Natus RetCam Envision, 130° FOV; infant wide-field retinal image
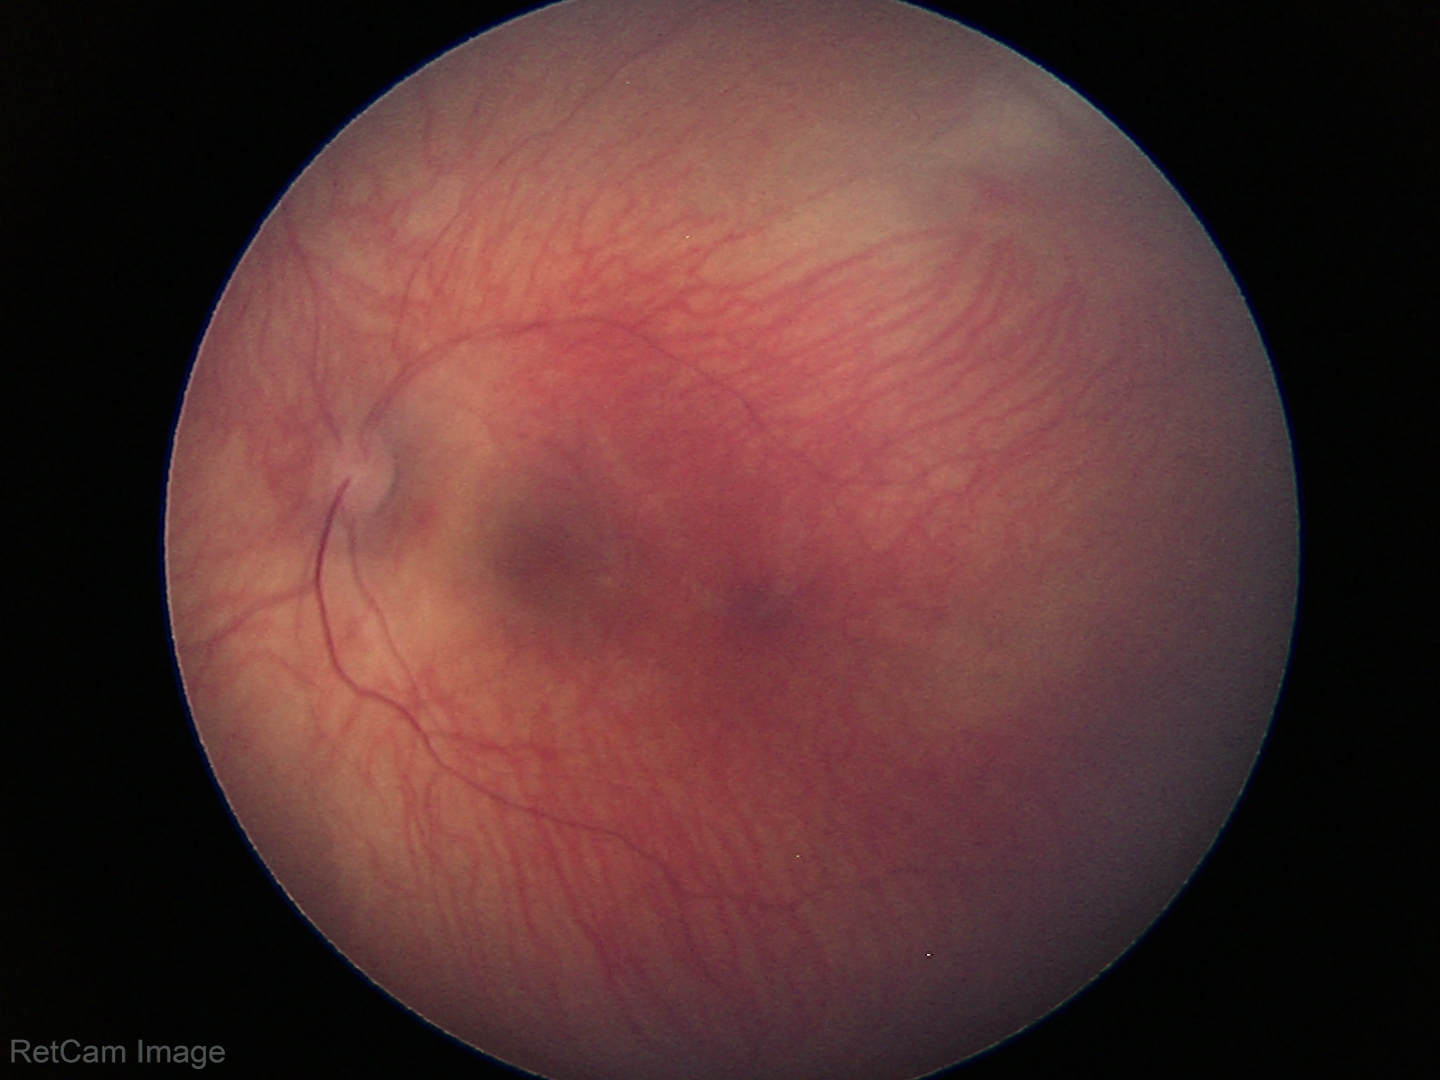 No retinal pathology identified on screening.